NIDEK AFC-230 fundus camera, DR severity per modified Davis staging:
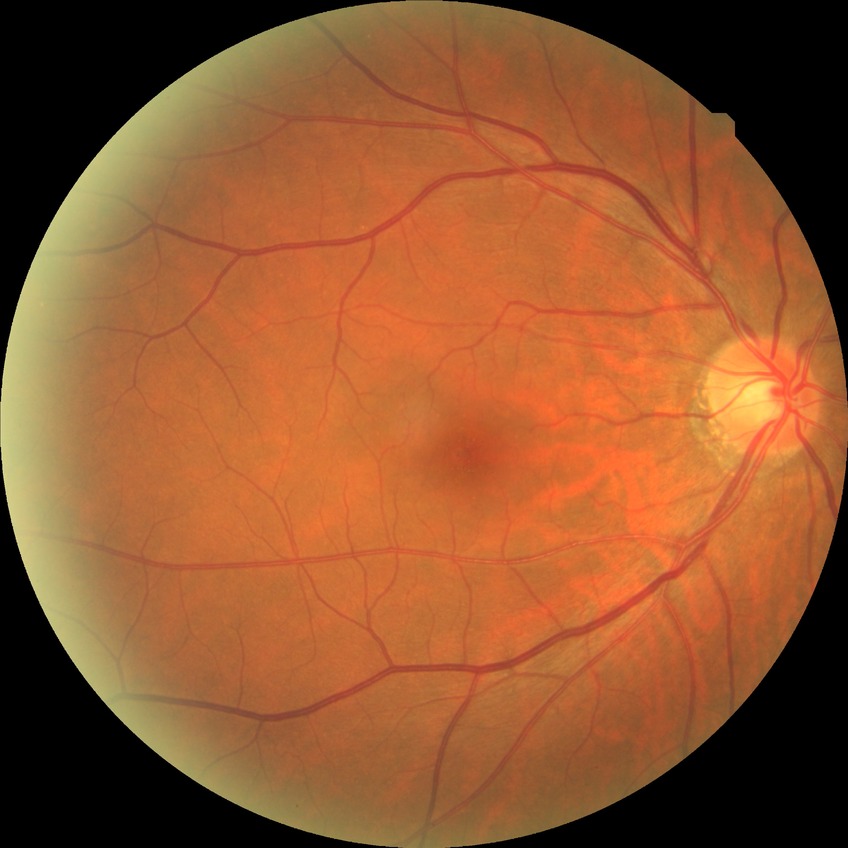

davis_grade: NDR (no diabetic retinopathy)